Wide-field contact fundus photograph of an infant.
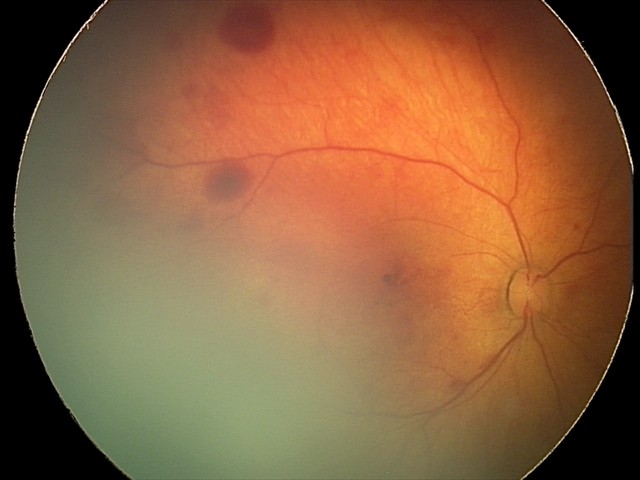 Diagnosis from this screening exam: retinal hemorrhages.